1932x1932.
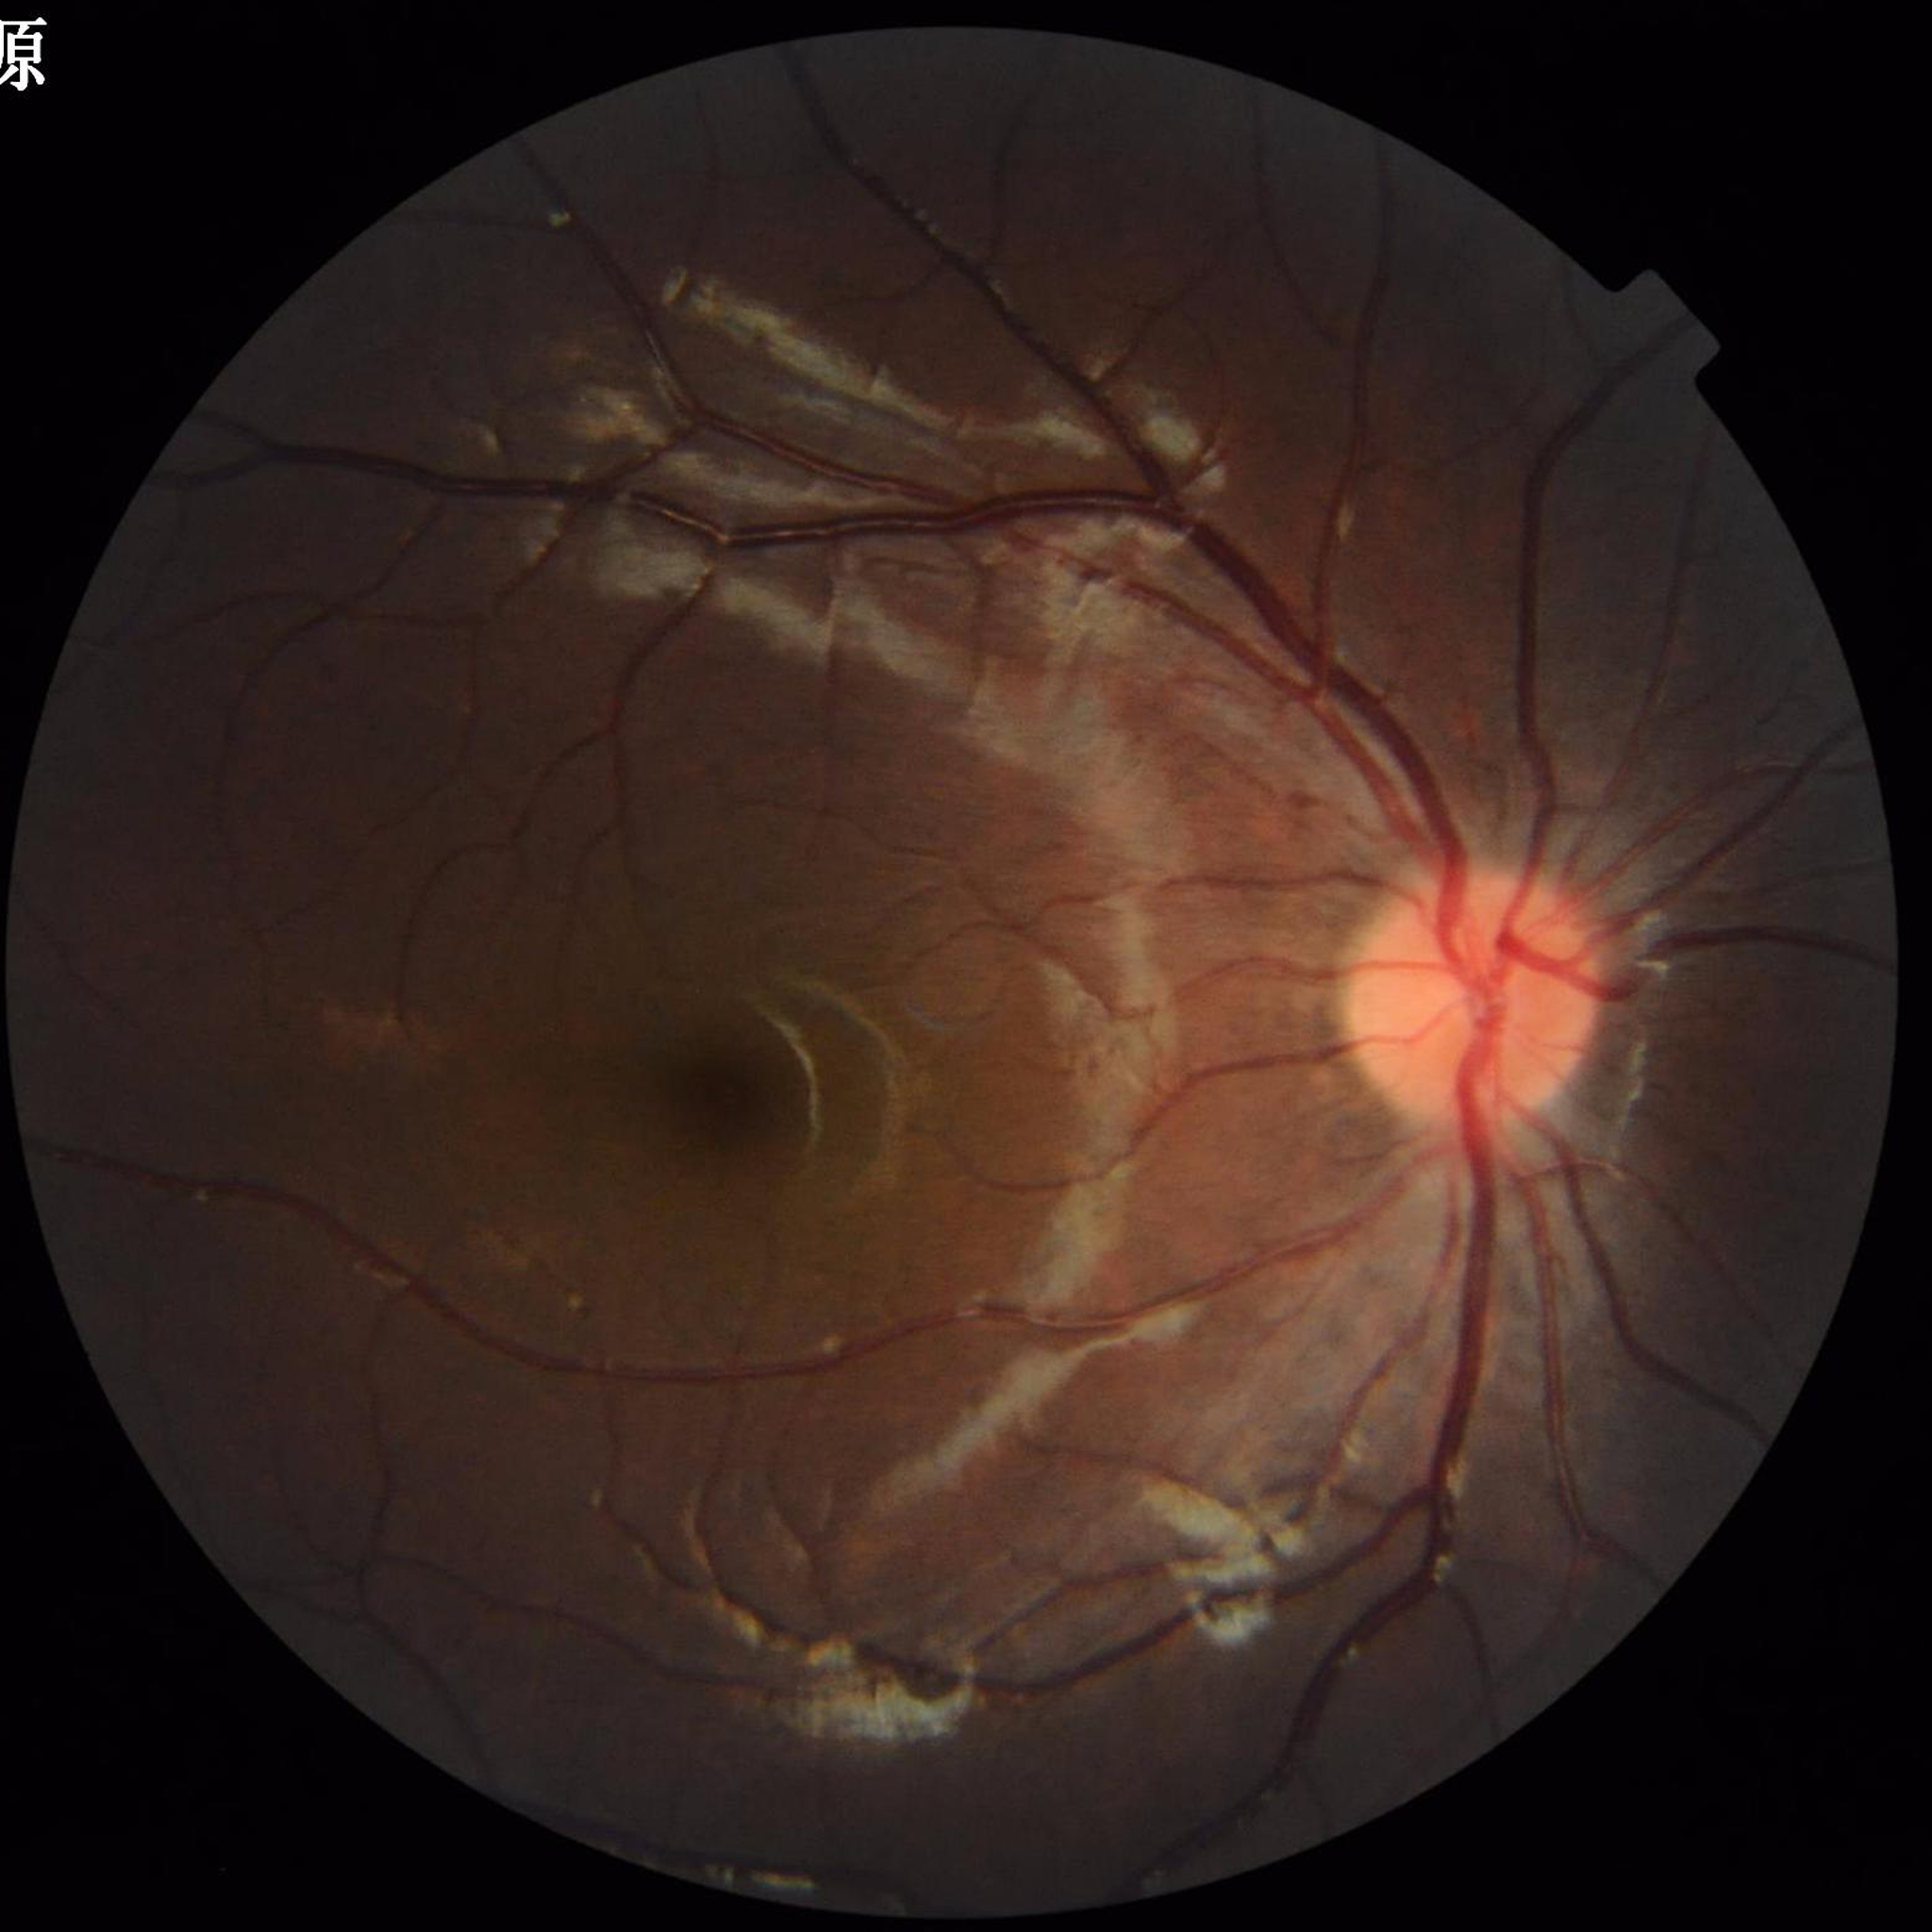 Clinical diagnosis: no AMD, DR, or glaucoma.